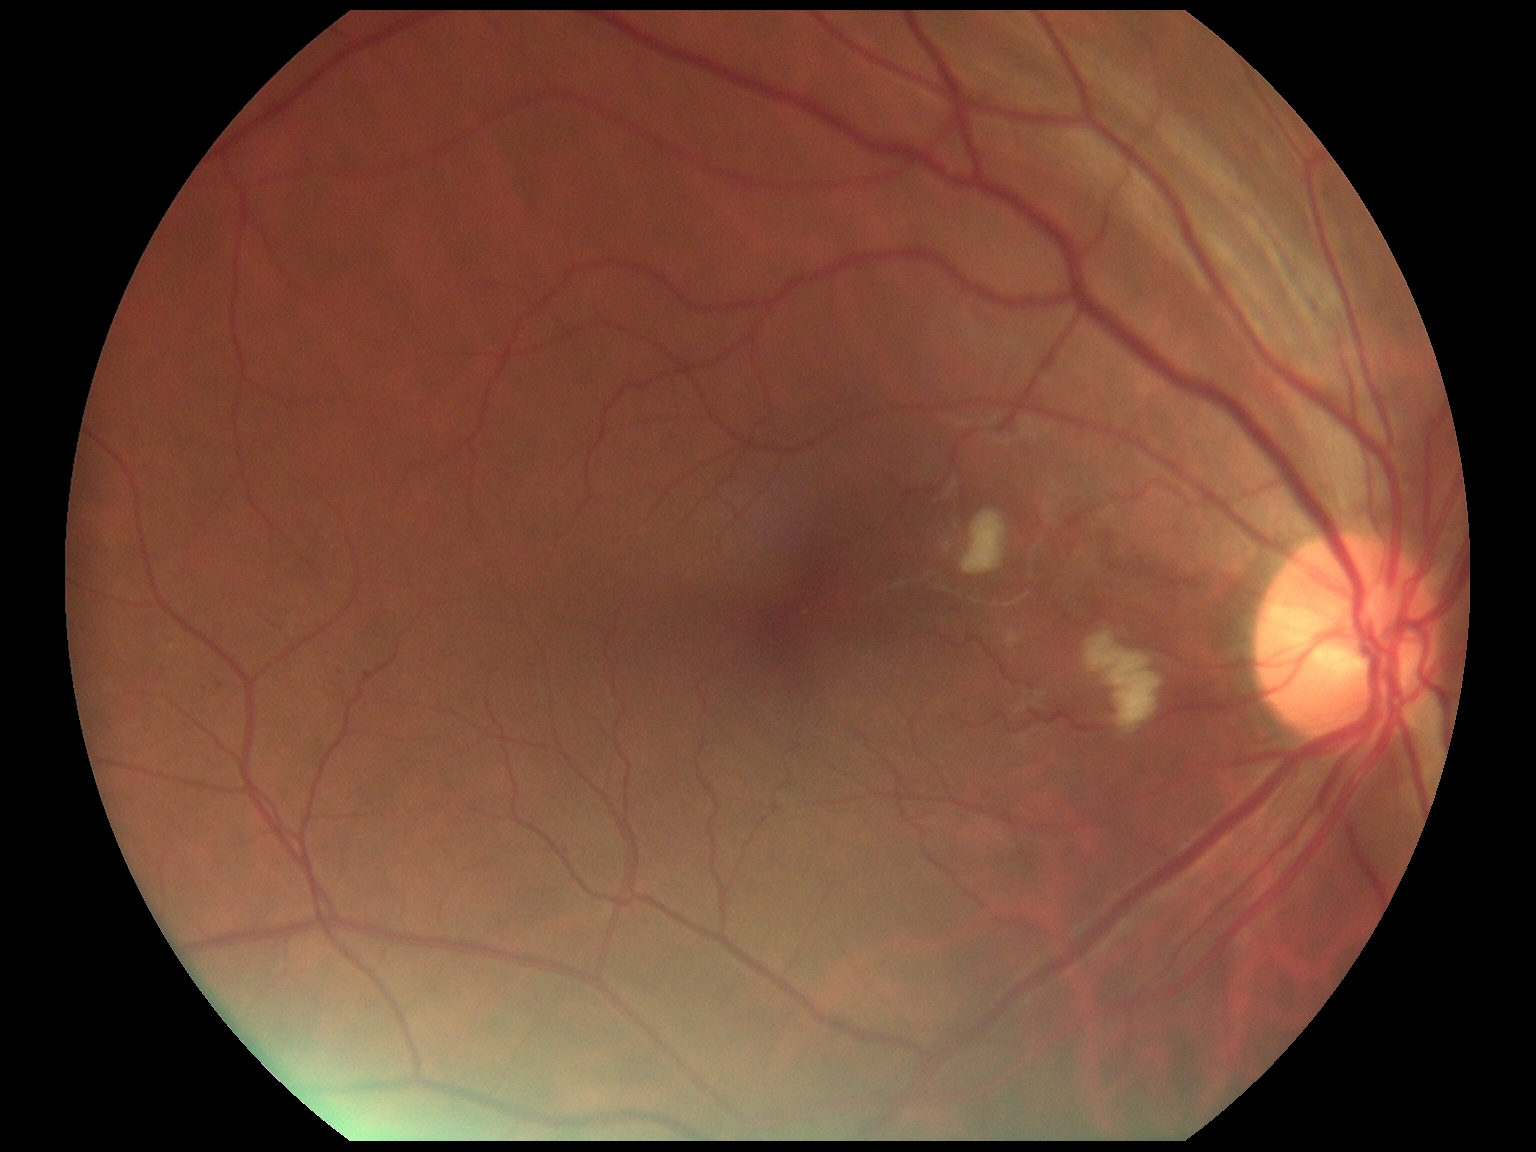

Diabetic retinopathy grade: moderate non-proliferative diabetic retinopathy (2) — more than just microaneurysms but less than severe NPDR.